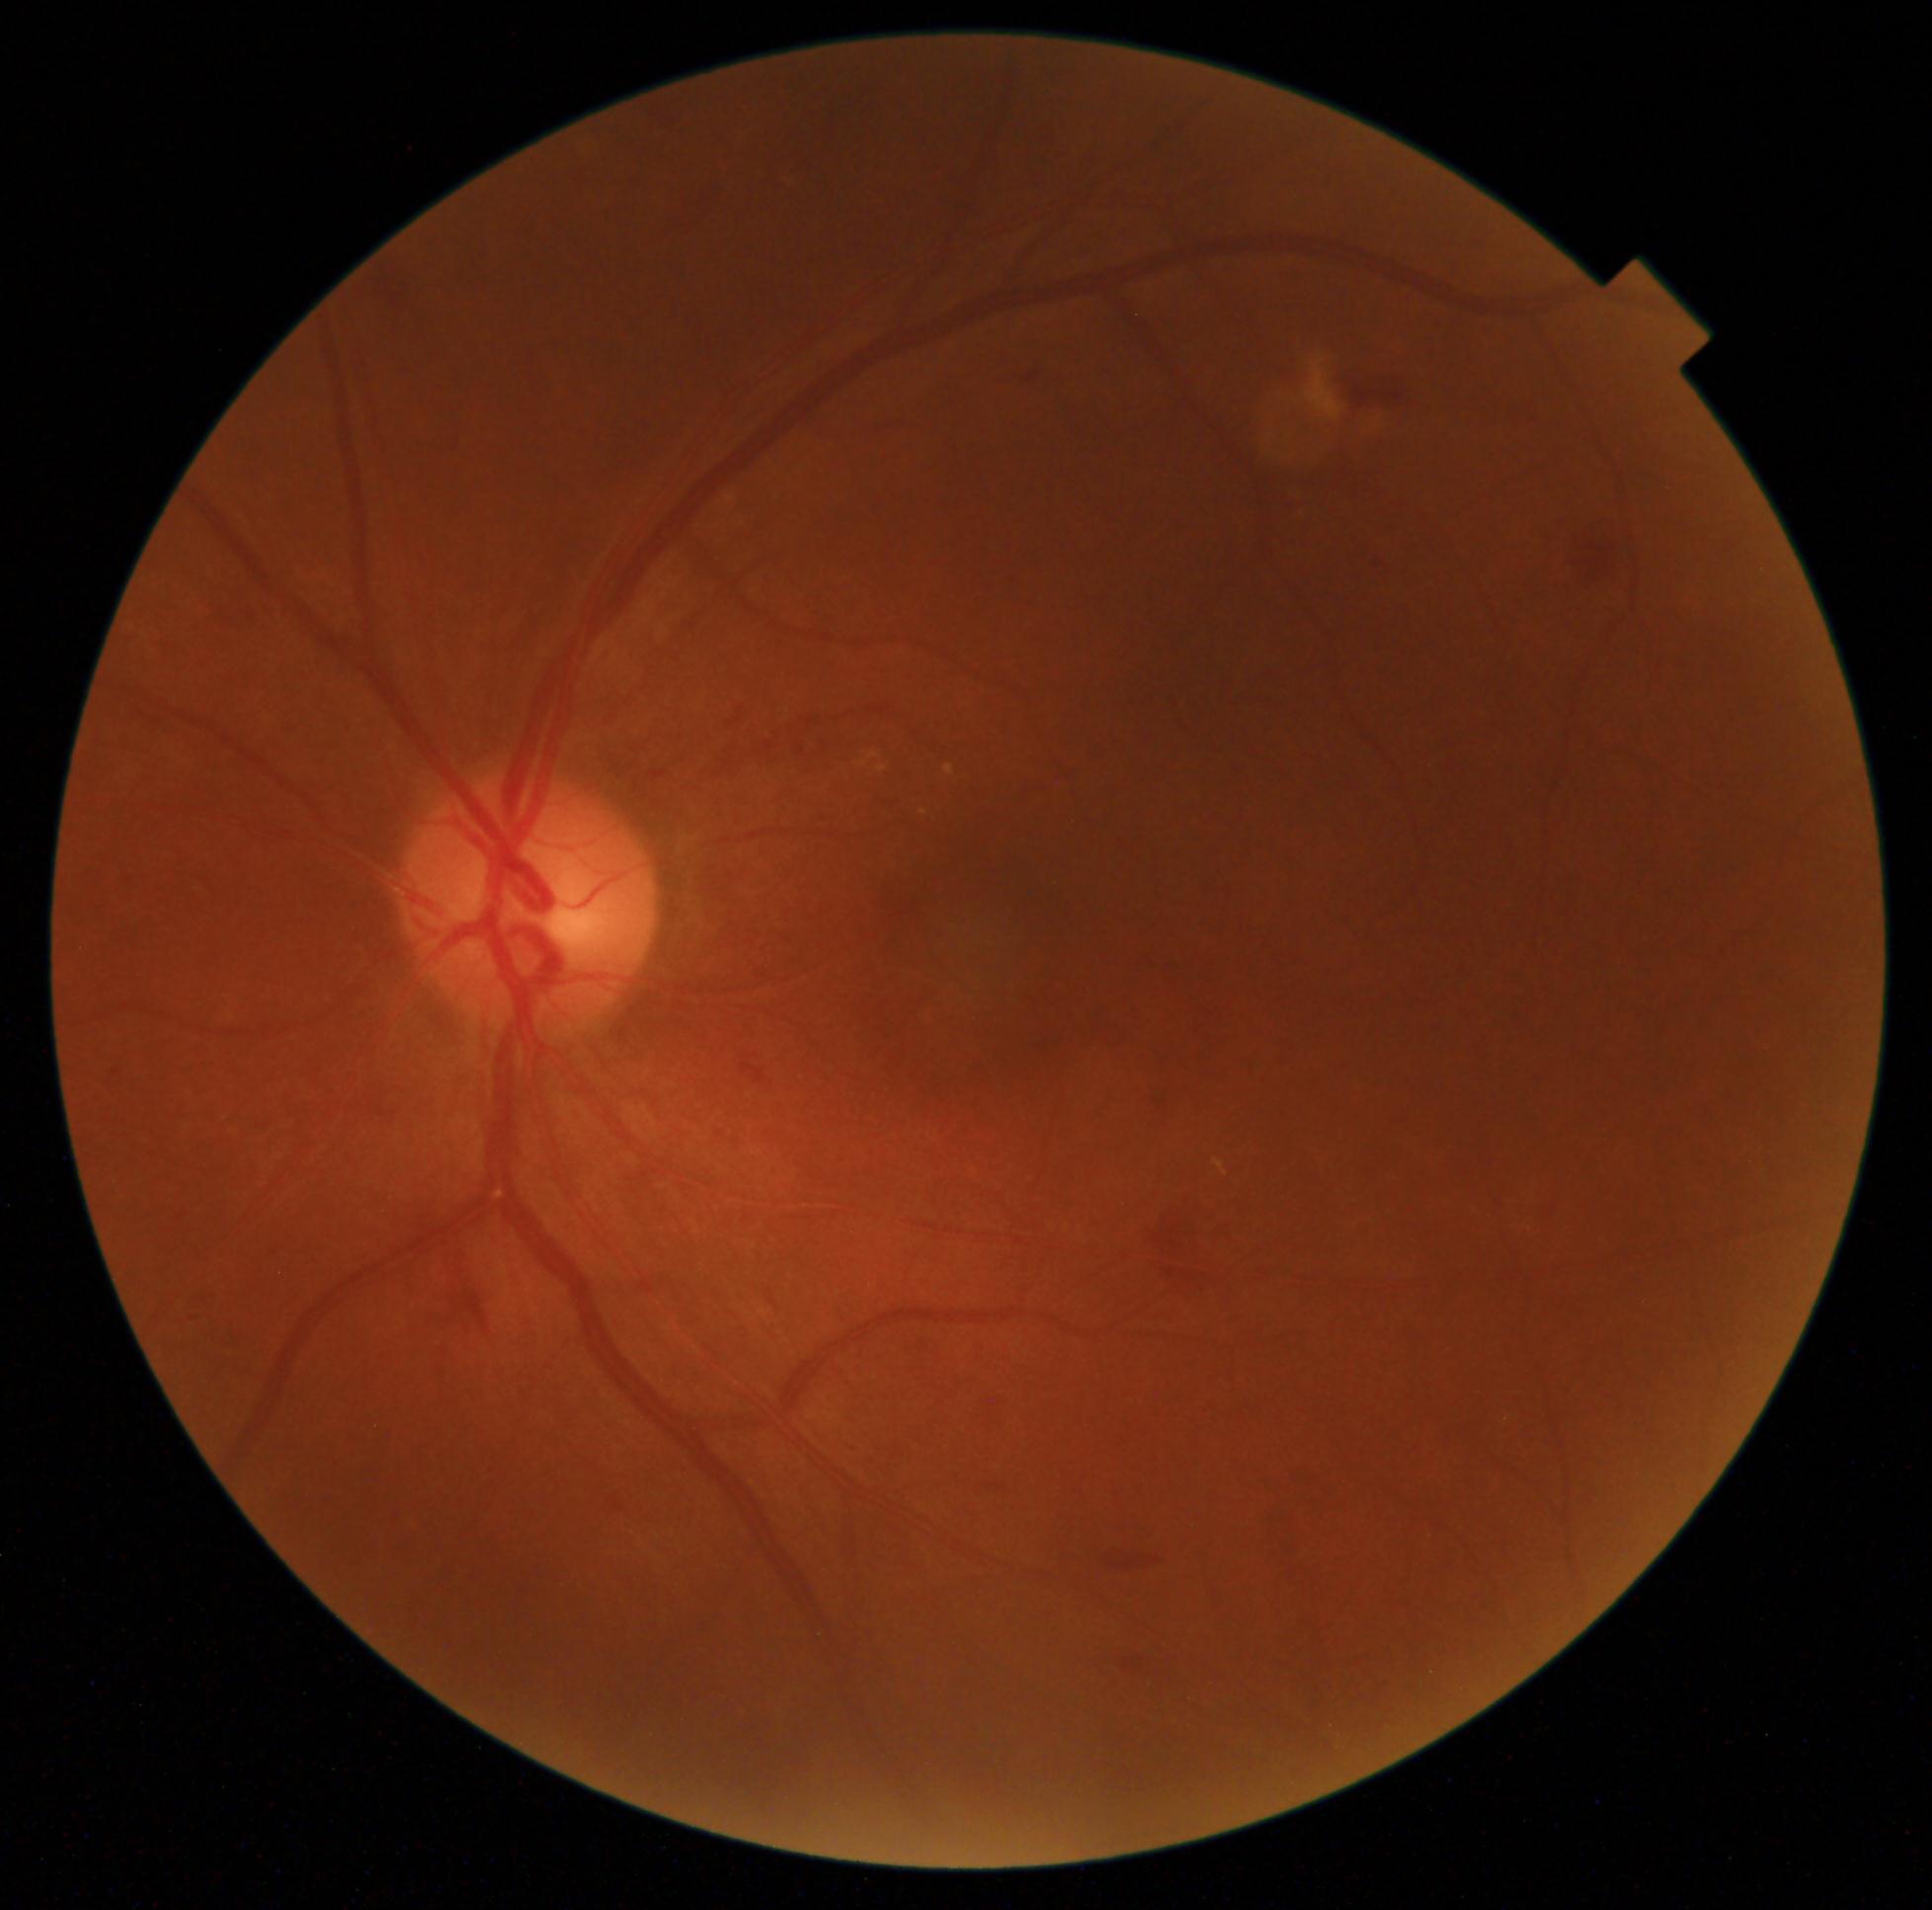

diabetic retinopathy (DR): moderate NPDR (grade 2) — more than just microaneurysms but less than severe NPDR | DR class: non-proliferative diabetic retinopathy.